Diabetic retinopathy graded by the modified Davis classification
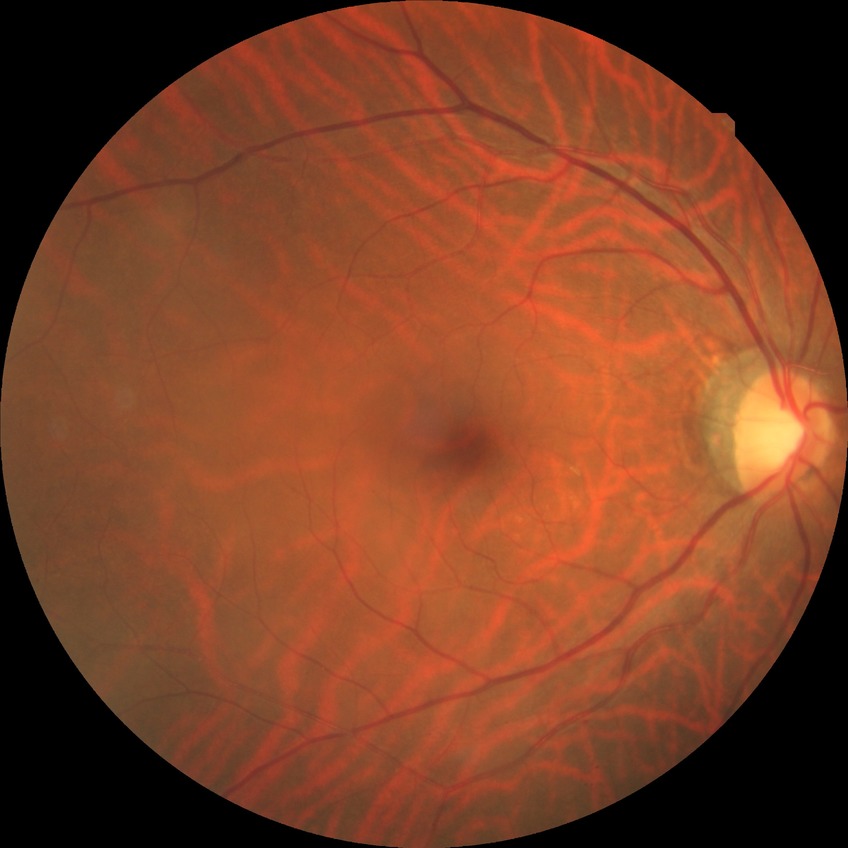

Assessment:
* modified Davis classification: no diabetic retinopathy